Camera: Clarity RetCam 3 (130° FOV) · 640 x 480 pixels · infant wide-field fundus photograph — 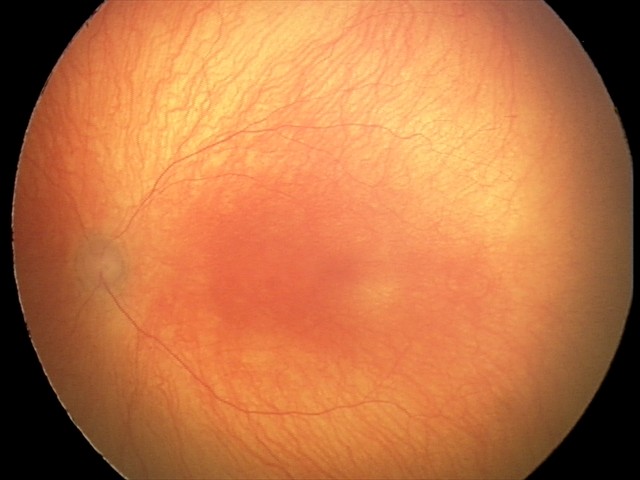

Diagnosis: aggressive retinopathy of prematurity